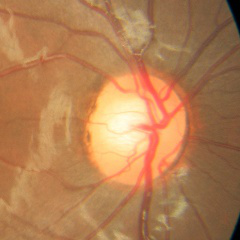

Q: What is the glaucoma diagnosis?
A: No — no signs of glaucoma.